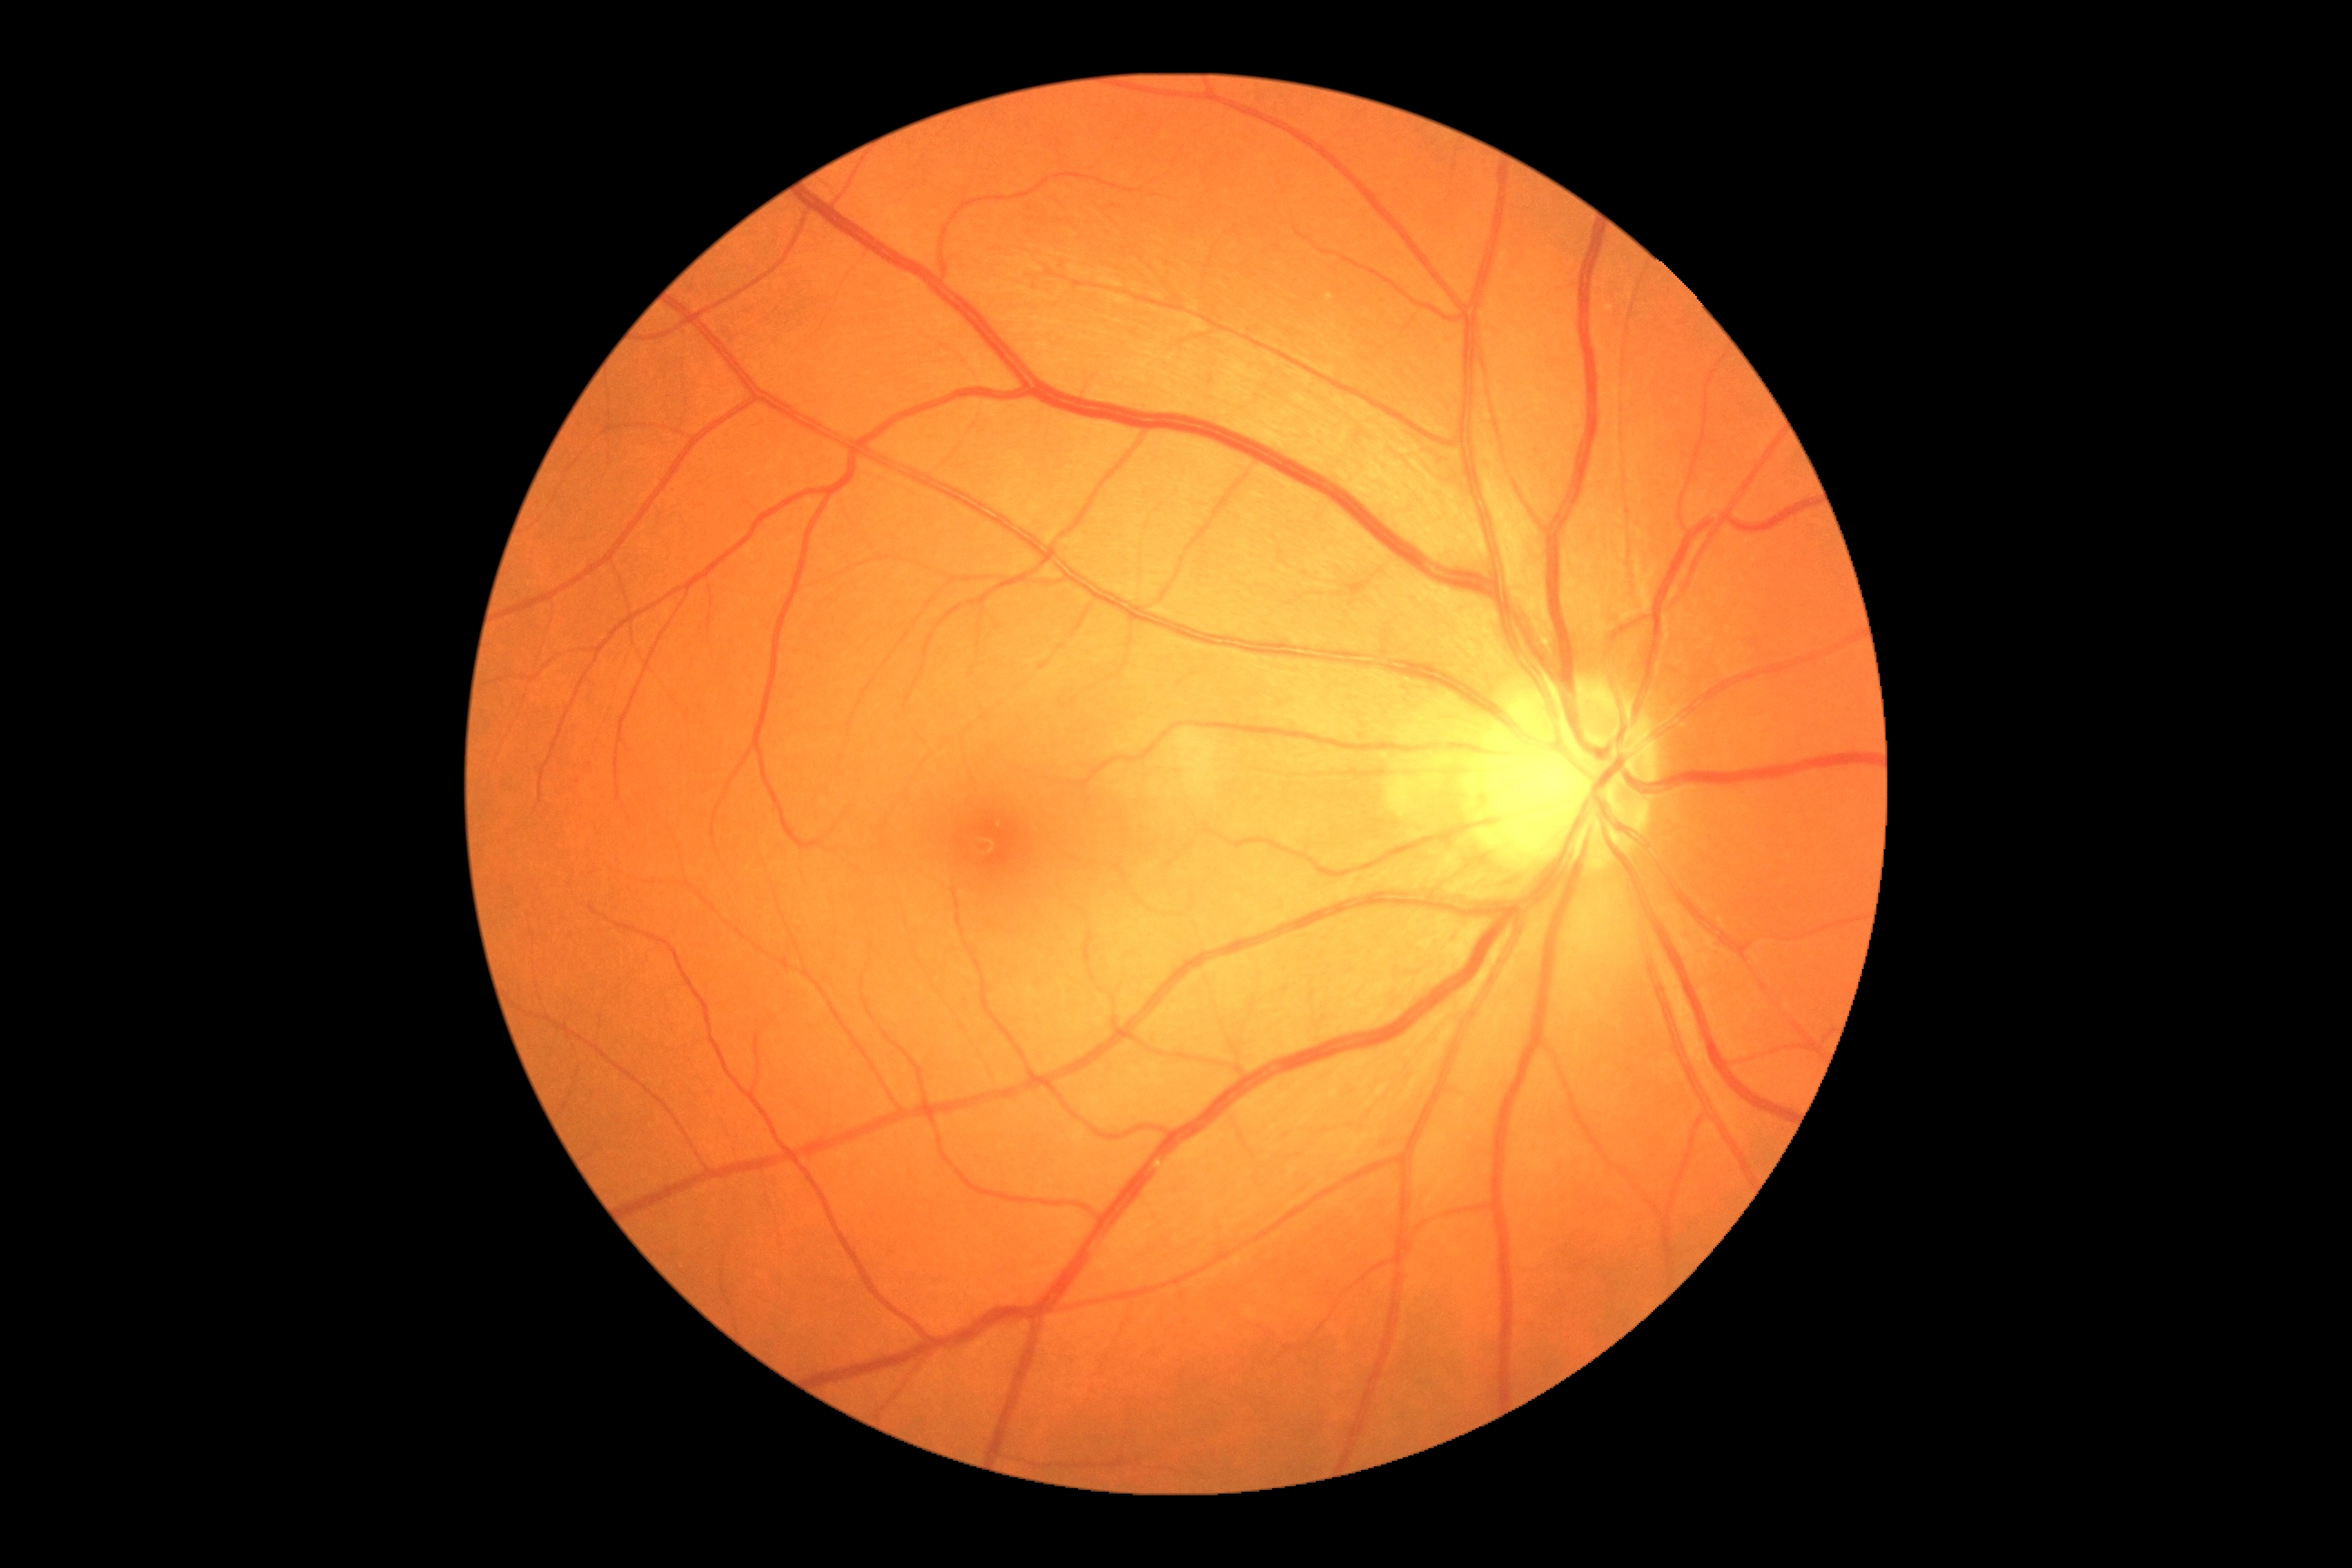
DR severity: no apparent diabetic retinopathy (grade 0).